Wide-field fundus image from infant ROP screening — 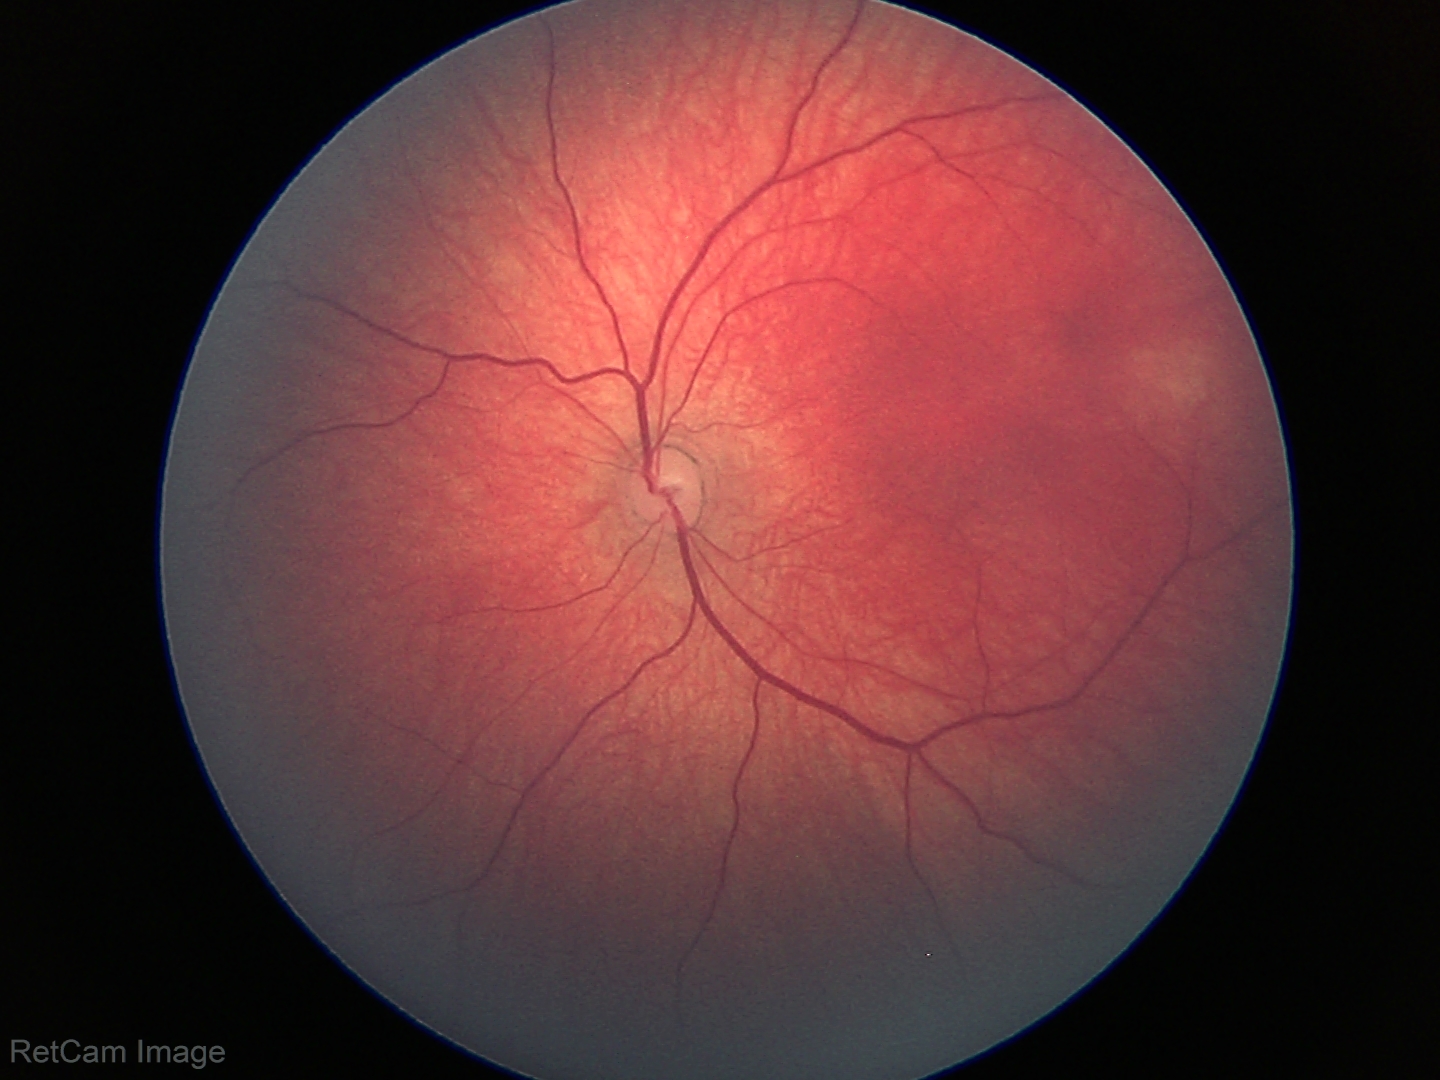
Q: What is the diagnosis from this examination?
A: physiological appearance with no retinal pathology